NIDEK AFC-230 fundus camera. Graded on the modified Davis scale. 45 degree fundus photograph. 848x848.
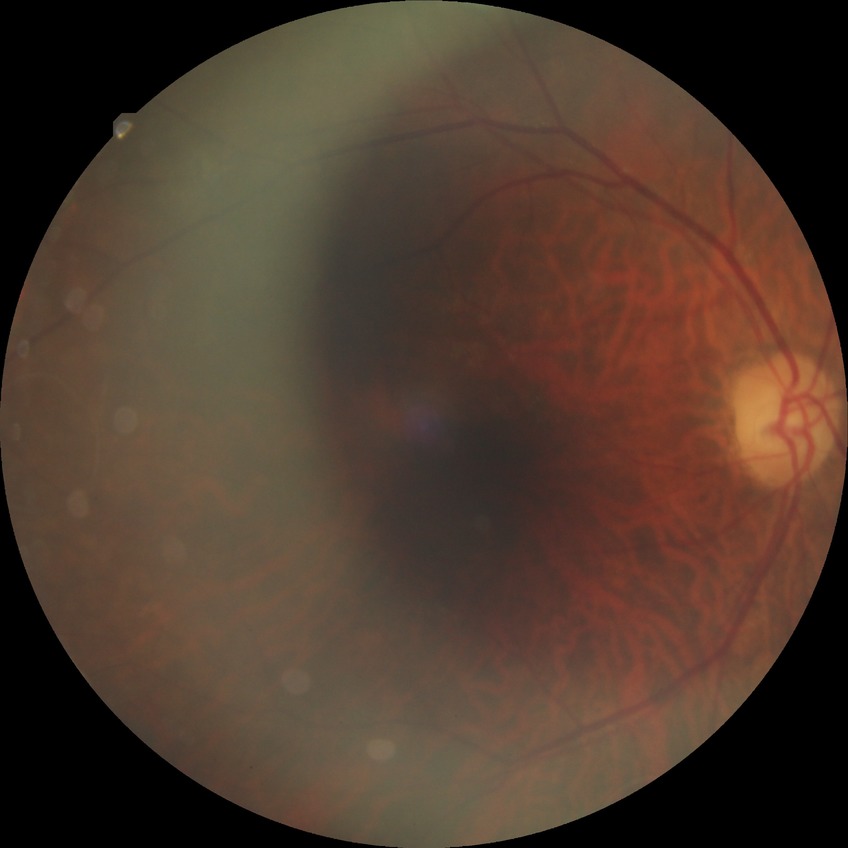
retinopathy stage@no diabetic retinopathy.